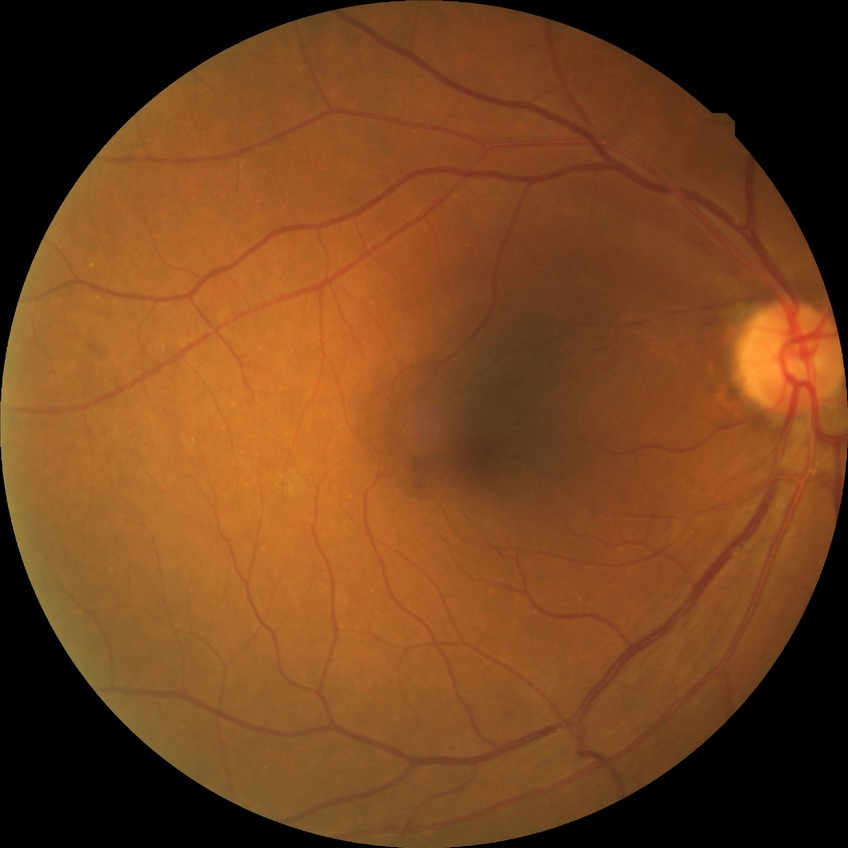 Modified Davis classification: simple diabetic retinopathy.